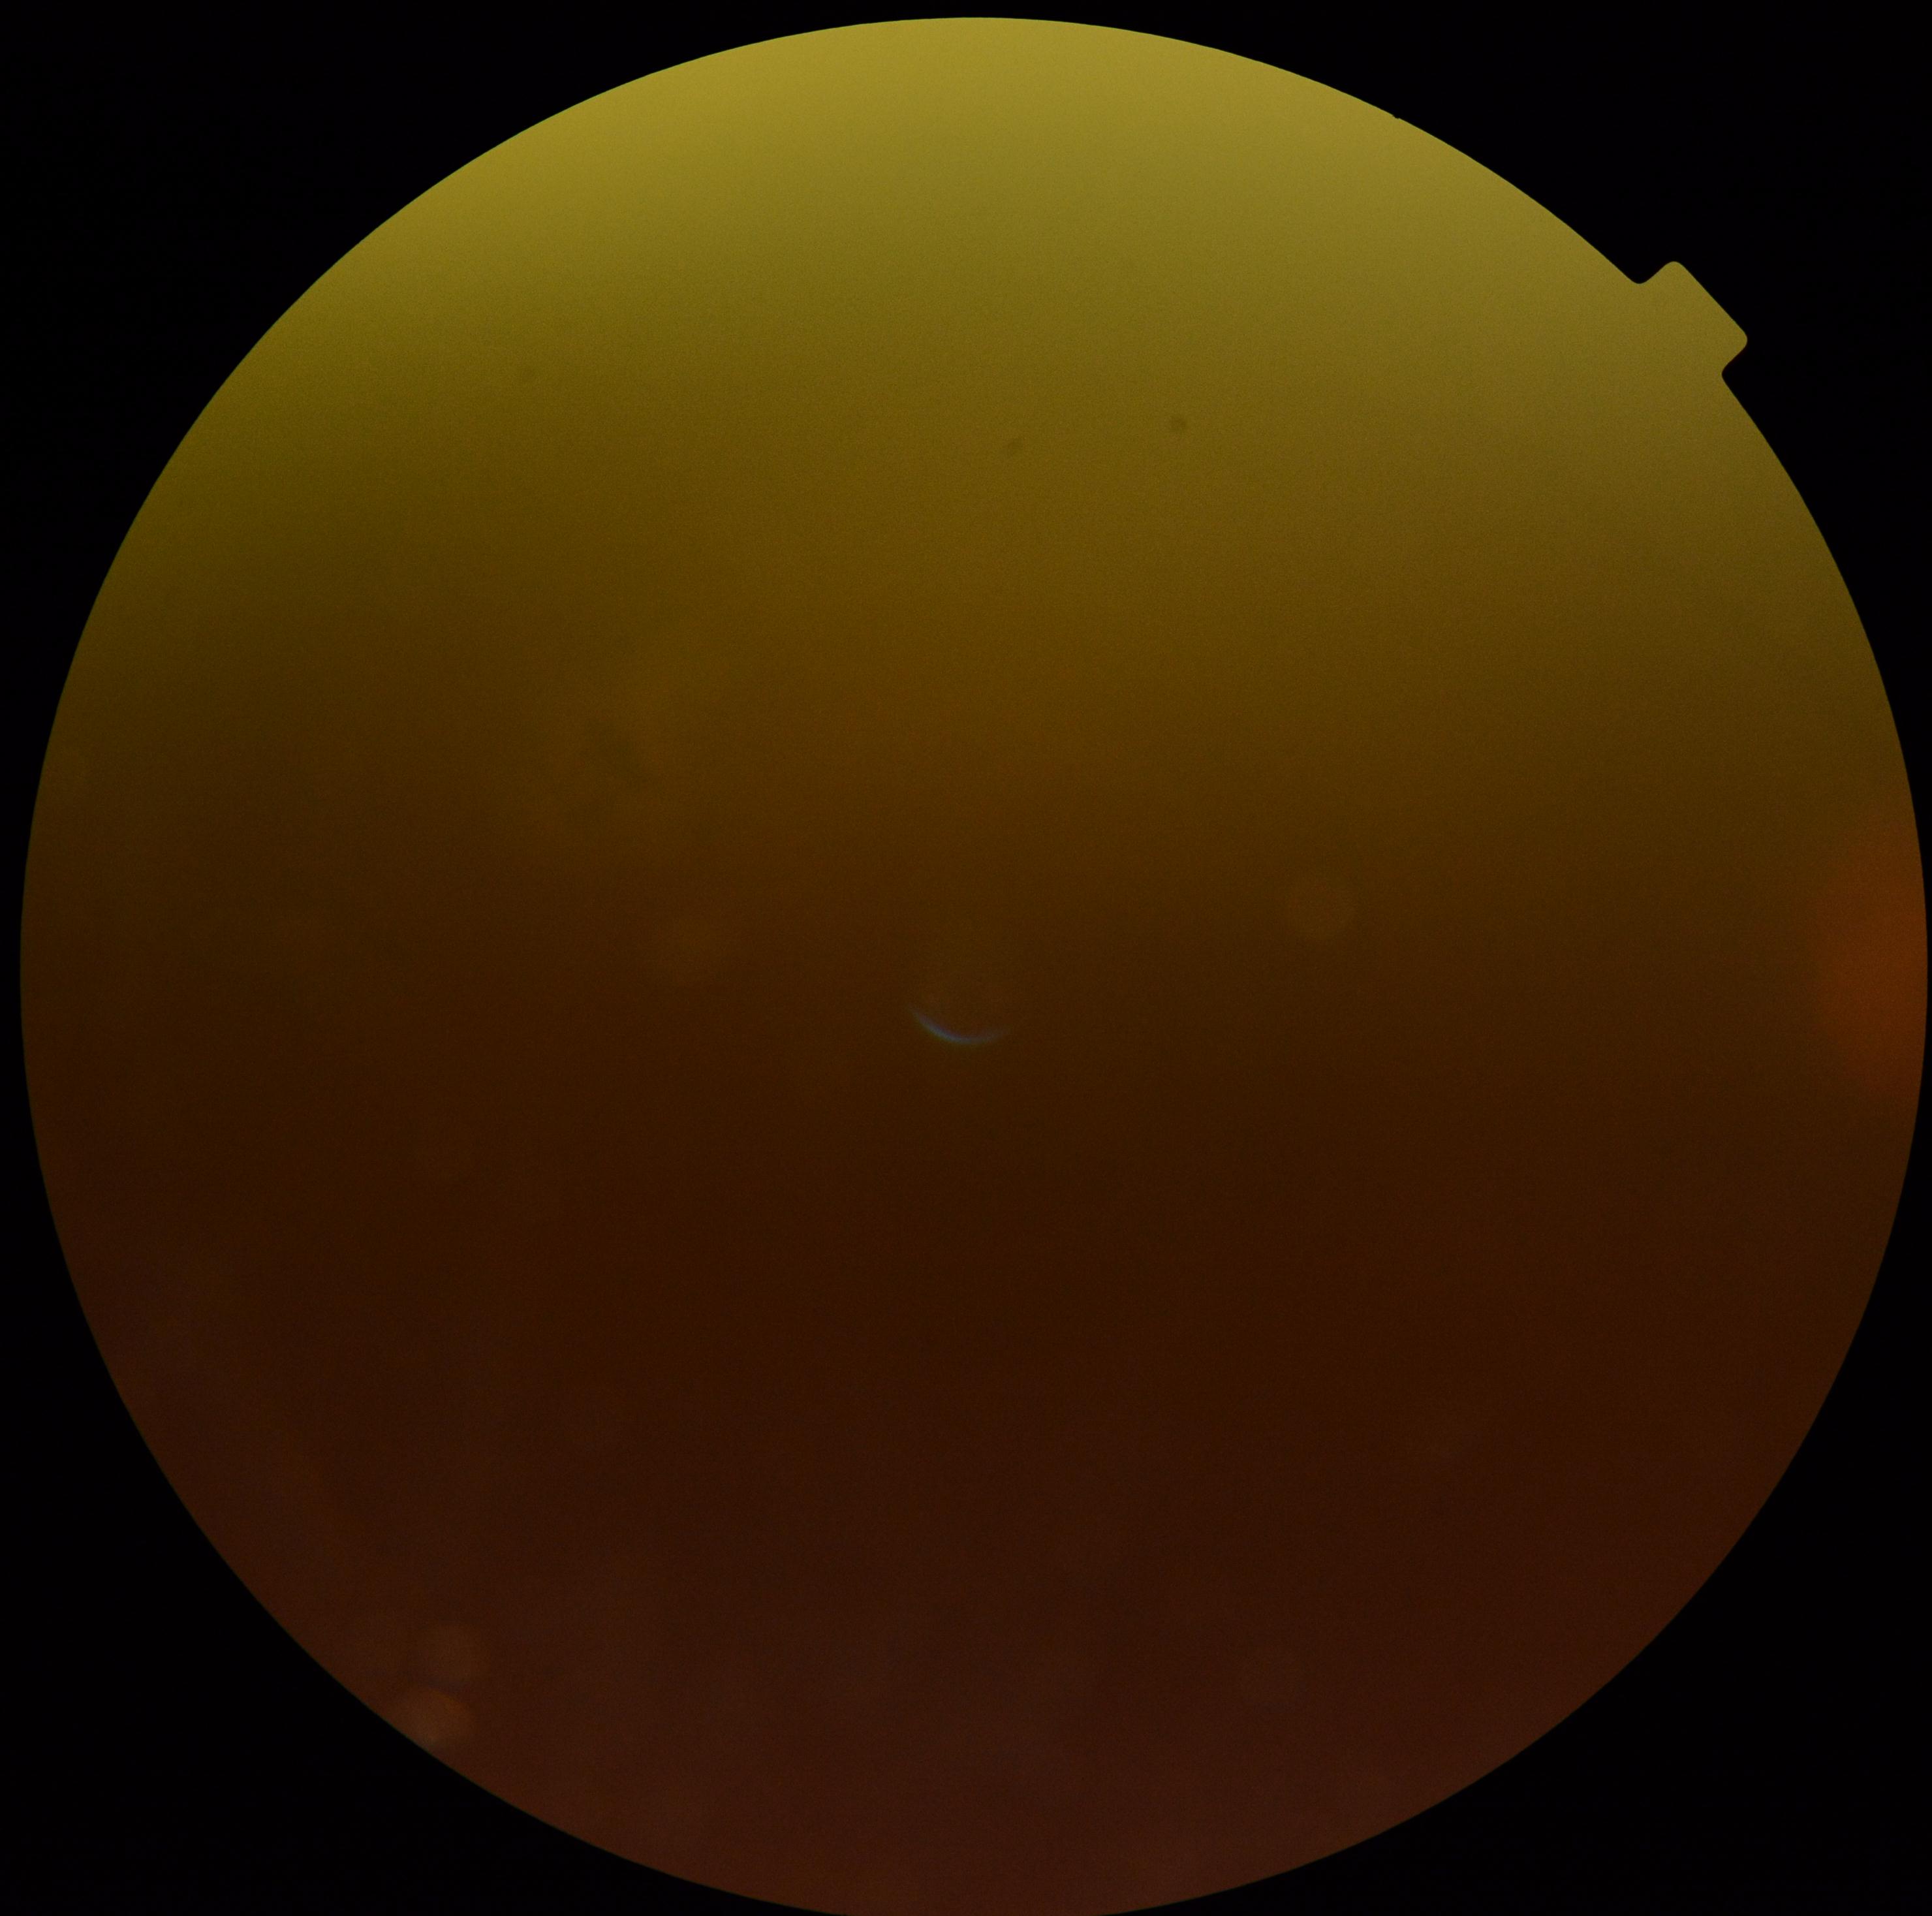

Ungradable image — DR severity cannot be determined. Diabetic retinopathy (DR): ungradable.